Retinal fundus photograph. Acquired with a NIDEK AFC-230:
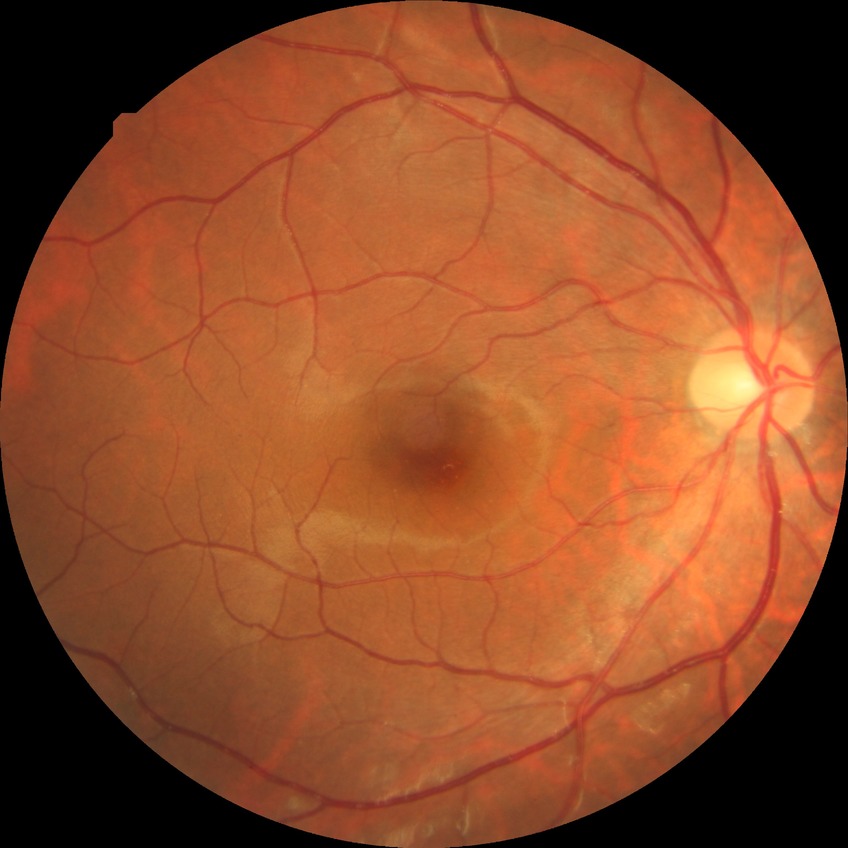

Davis grading: no diabetic retinopathy.